Nonmydriatic:
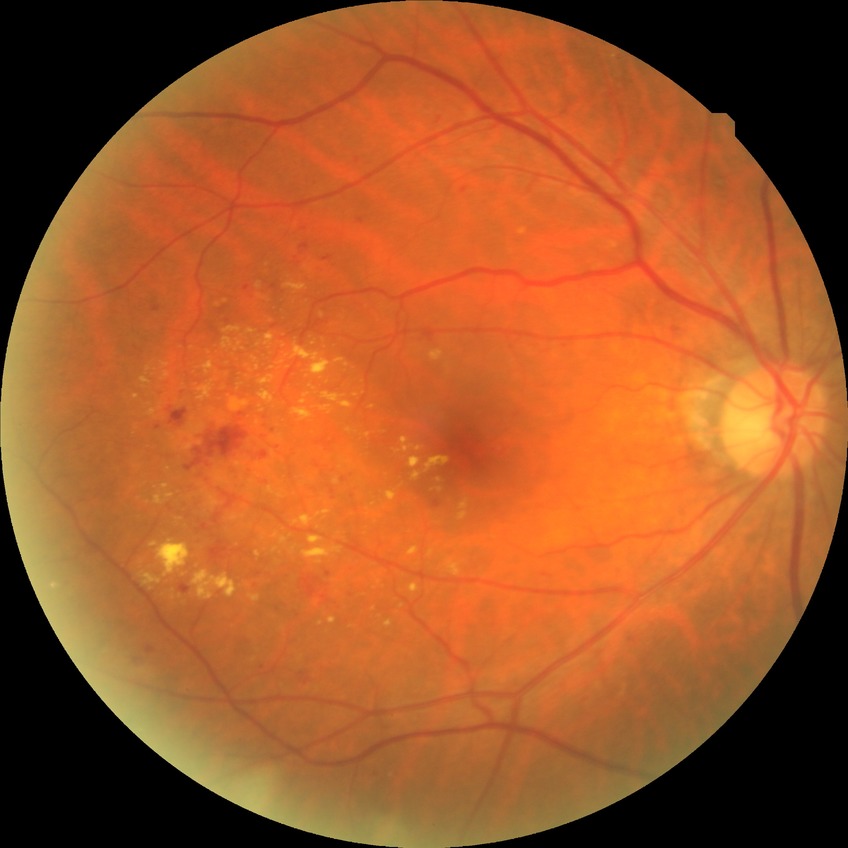 Modified Davis grading is simple diabetic retinopathy.